Fundus photo.
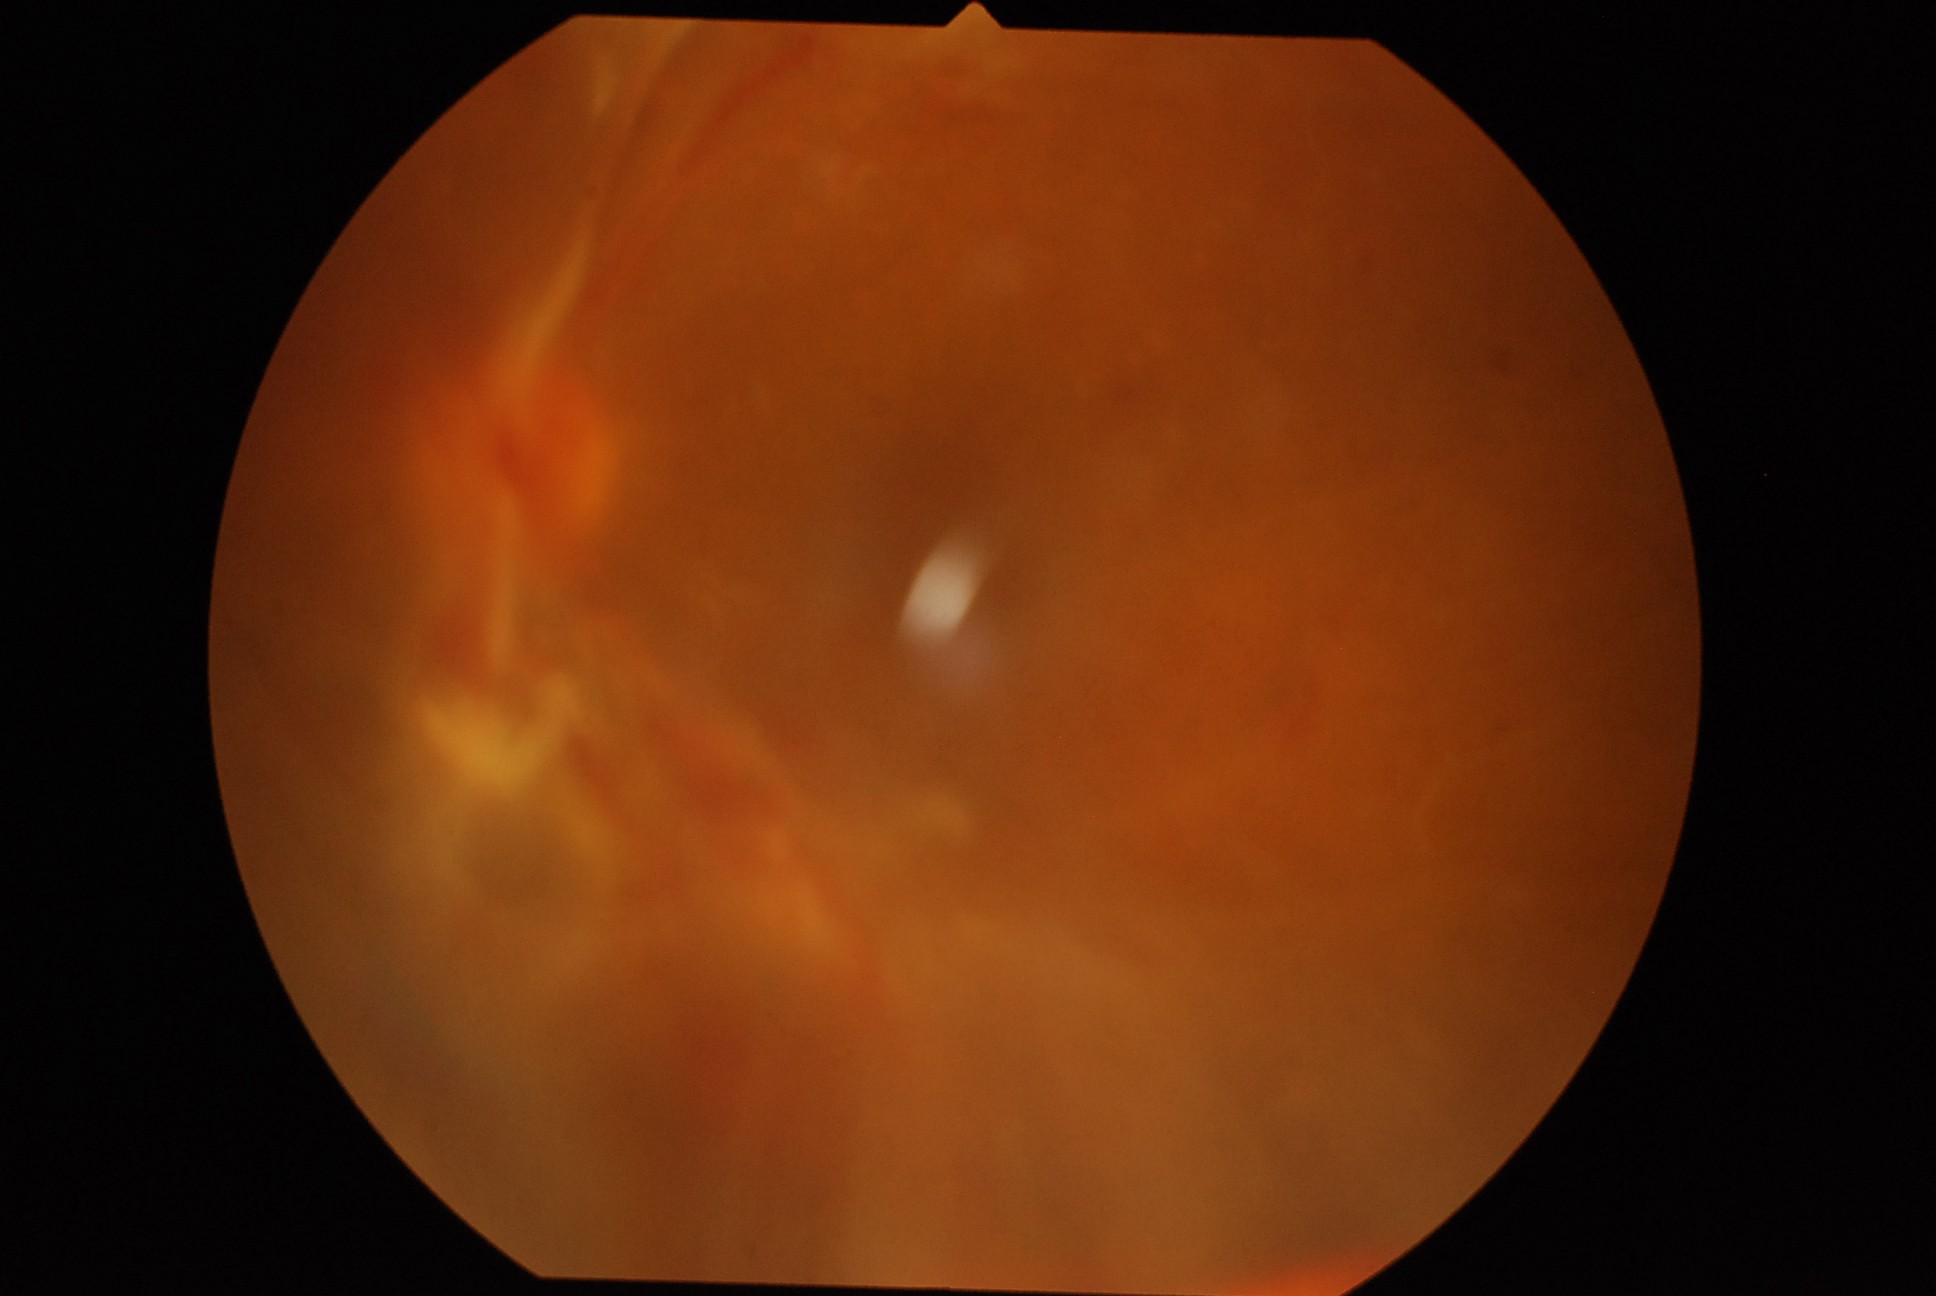

Annotations:
• DR grade: 4 — neovascularization and/or vitreous/pre-retinal hemorrhage